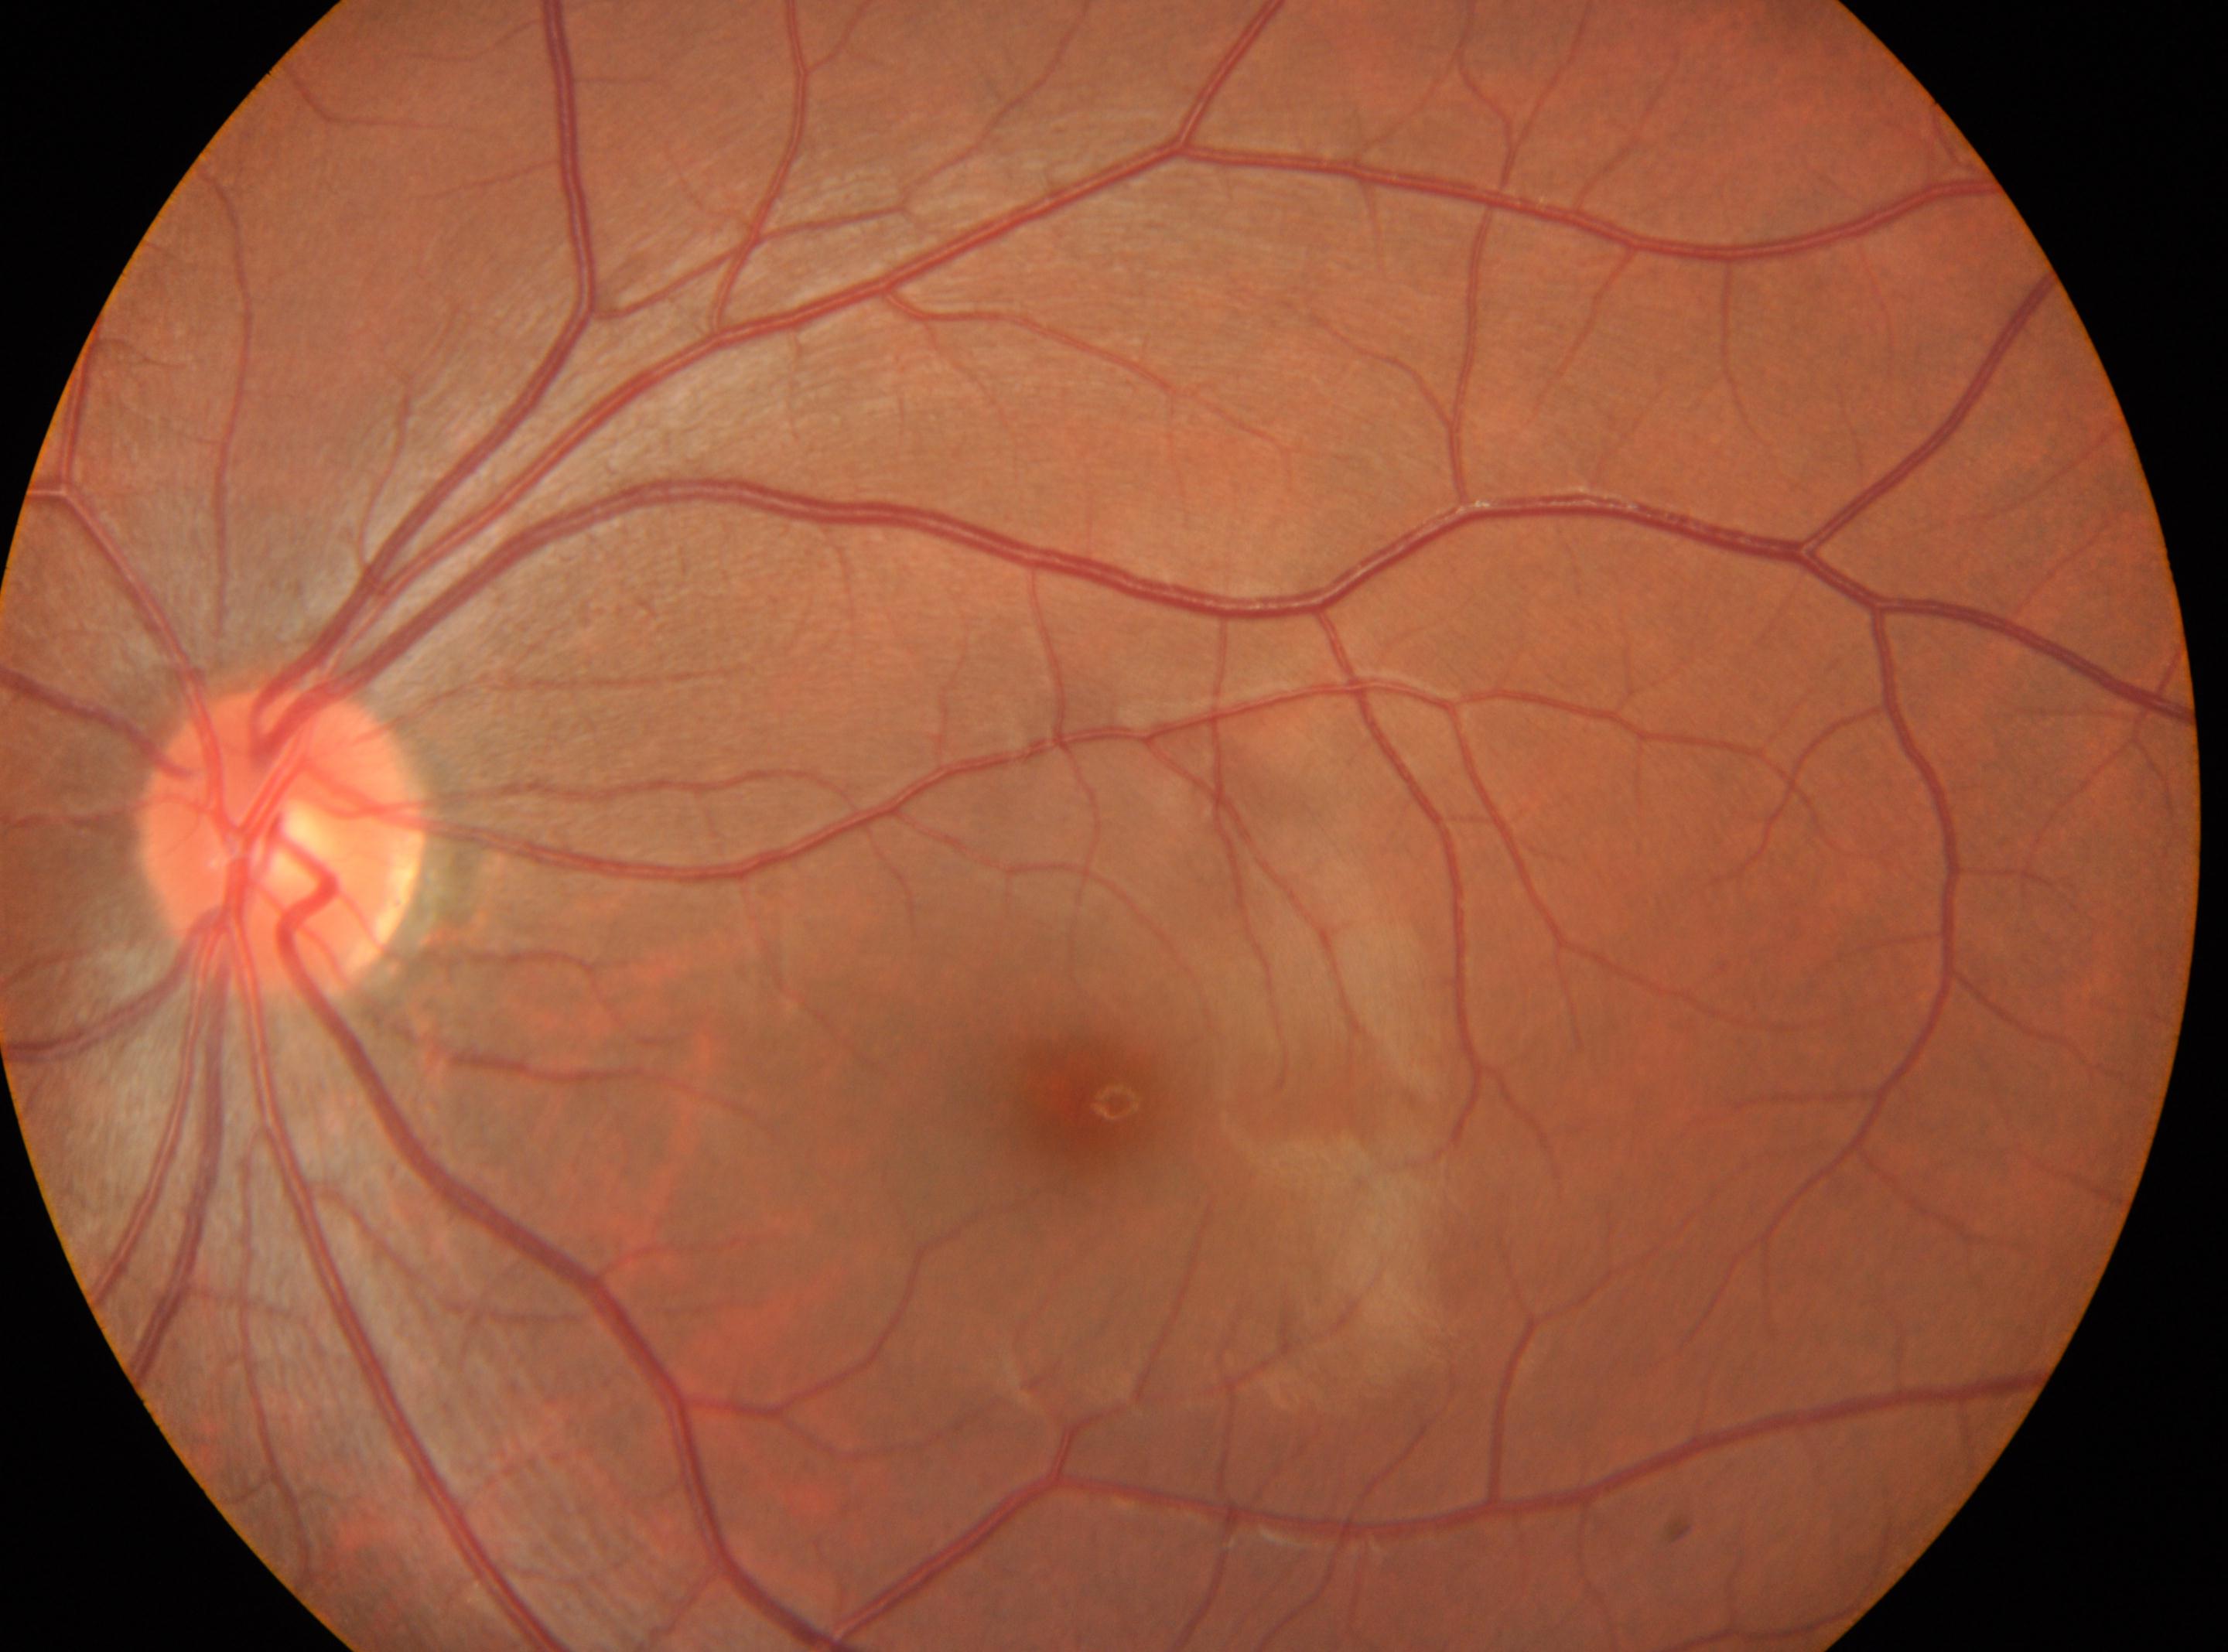
| field | value |
|---|---|
| the fovea | (1092,1100) |
| eye | OS |
| optic disc center | (285,845) |
| diabetic retinopathy (DR) | no apparent retinopathy (grade 0) |